Captured after pupil dilation. Camera: Kowa VX-10α.
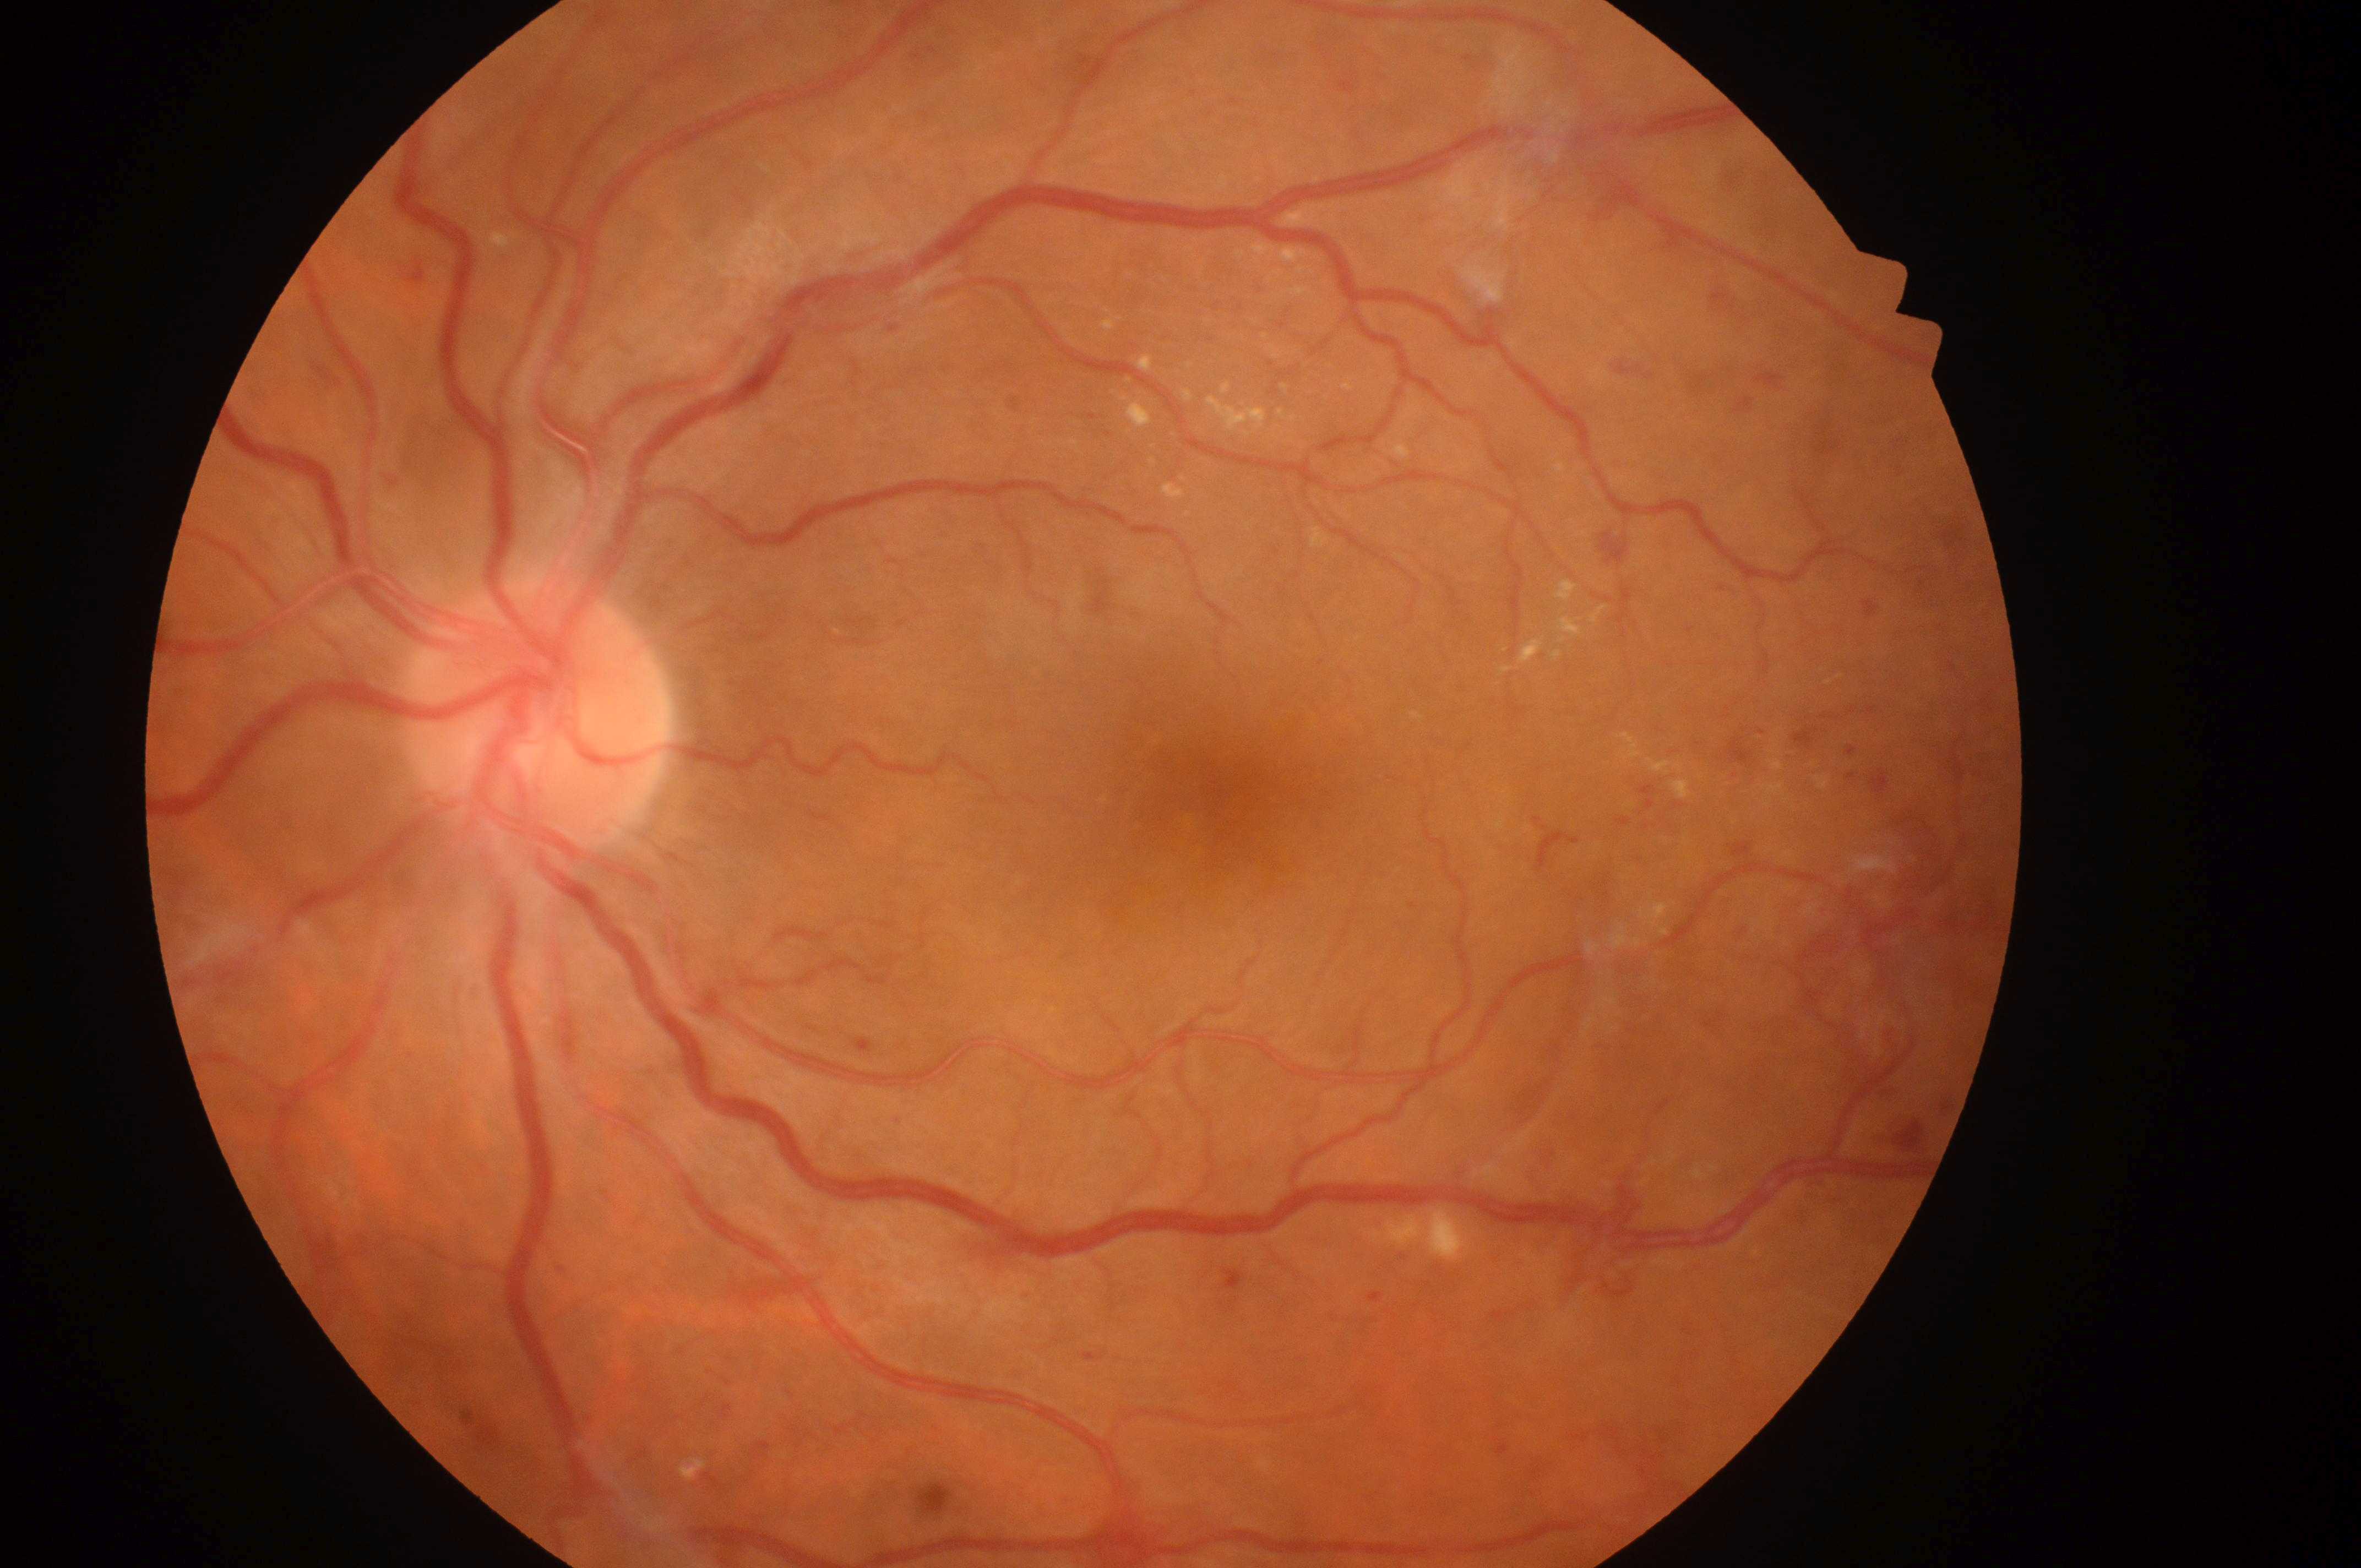

The disc center is at (x: 532, y: 723). The fovea is at (x: 1219, y: 802). DME risk is 2. DR severity: 4/4. The image shows the oculus sinister.